CFP, 45-degree field of view, image size 2048x1536.
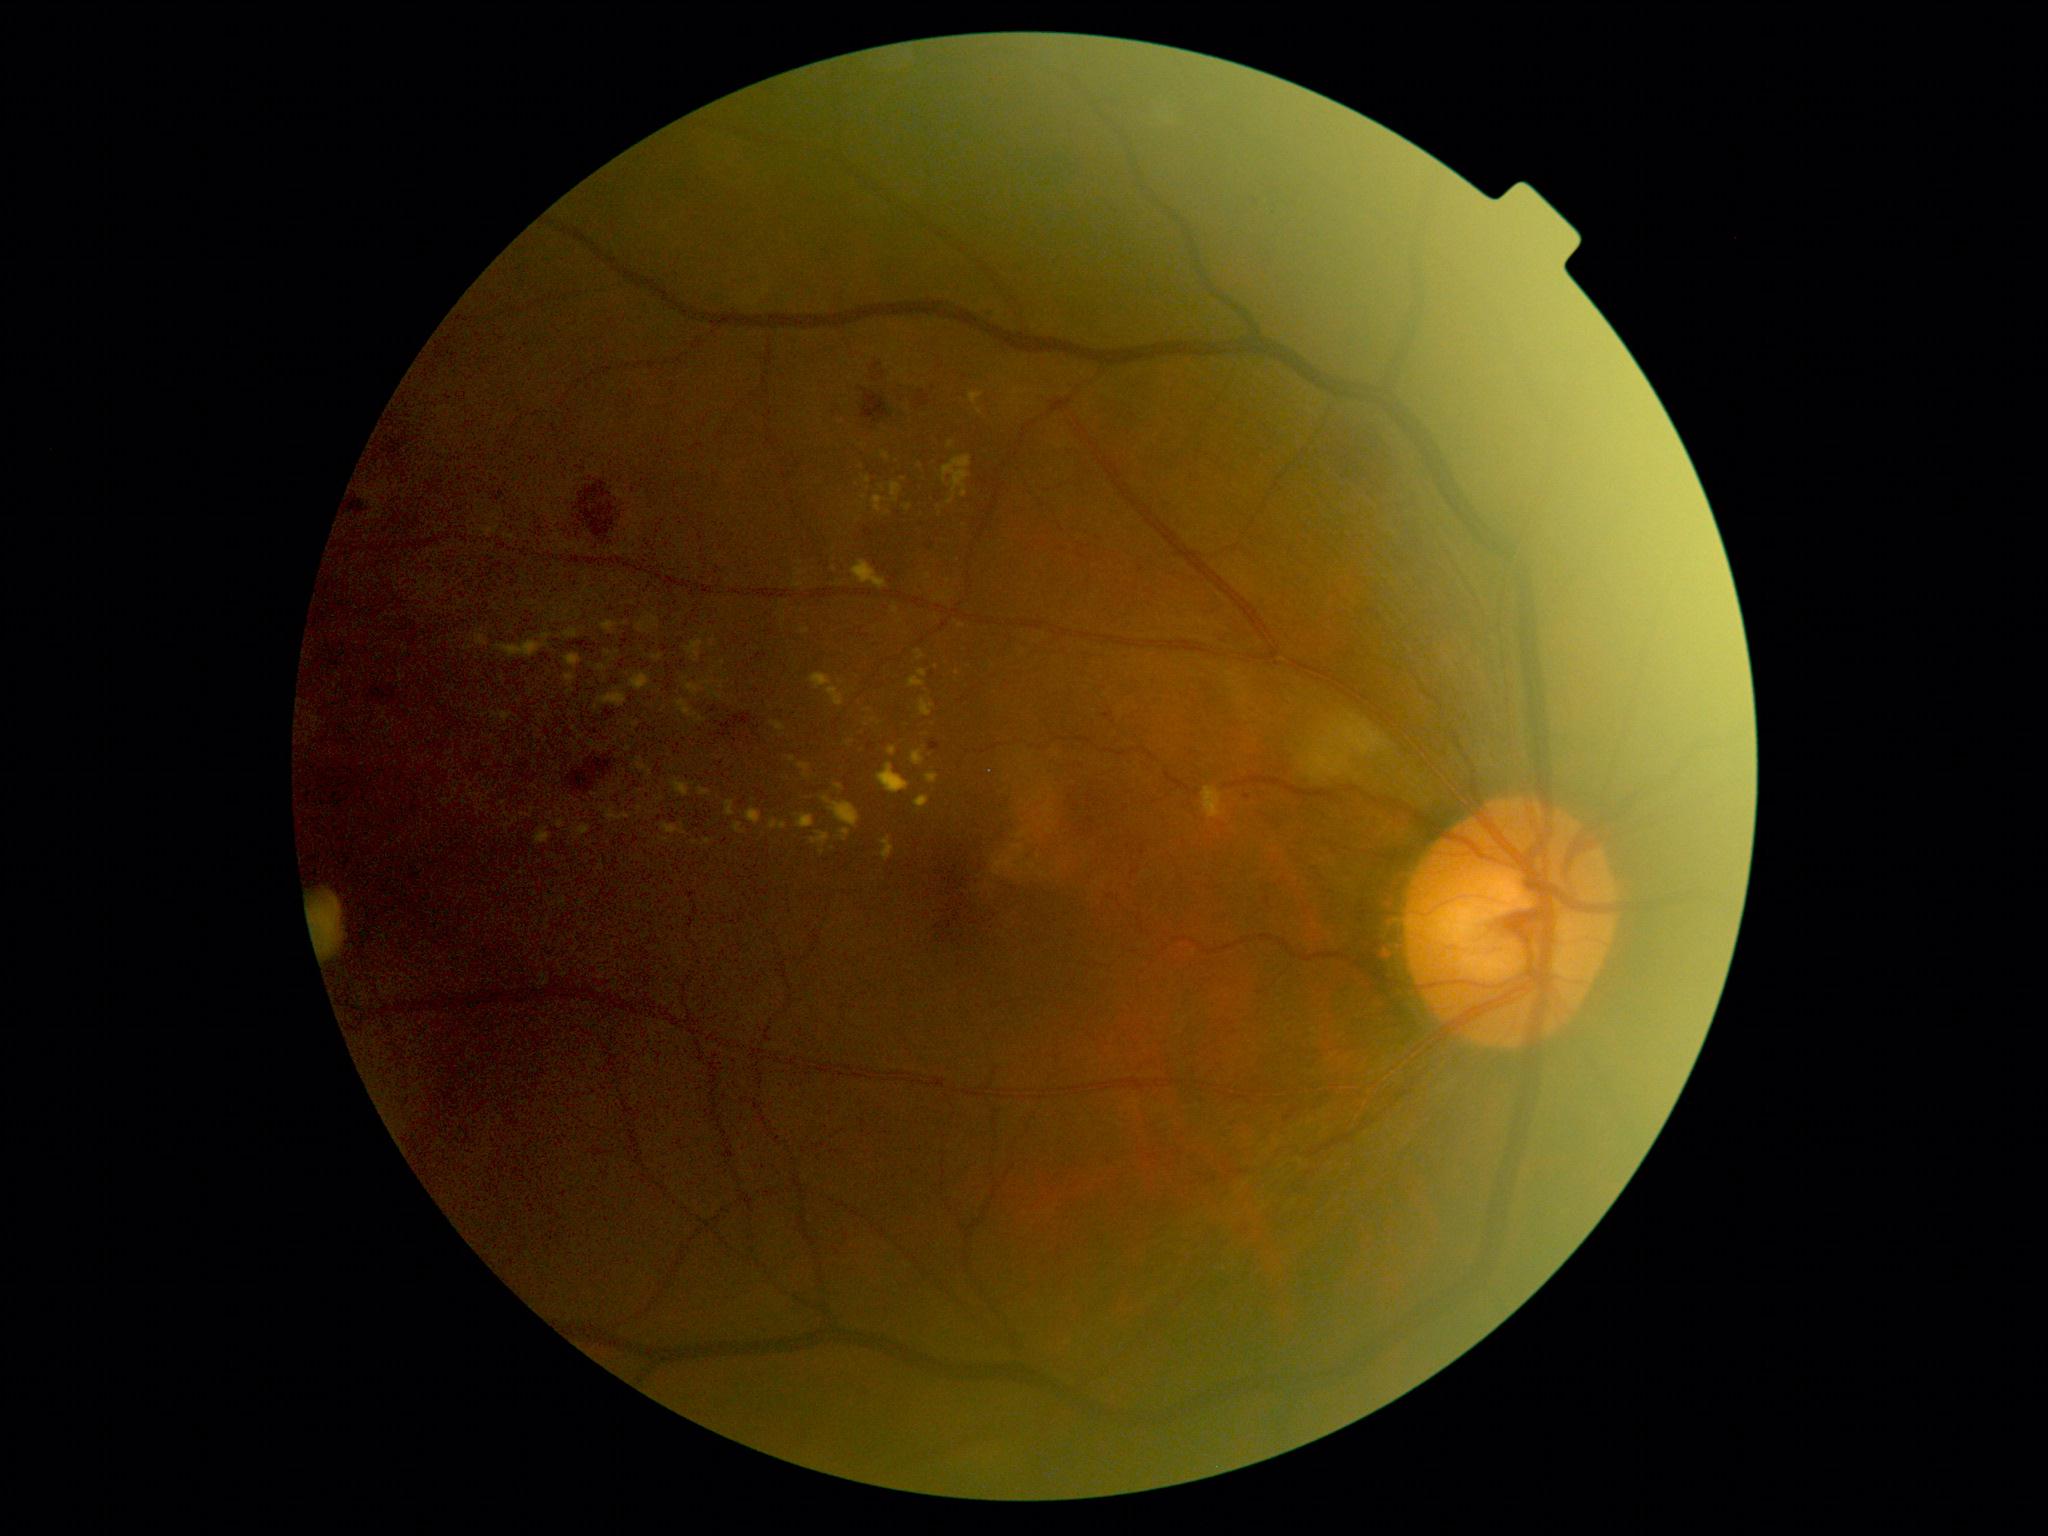 <lesions partial="true">
  <dr_grade>2</dr_grade>
  <ex partial="true">box(831, 803, 860, 828); box(687, 685, 699, 692); box(920, 702, 933, 717); box(883, 839, 895, 859); box(915, 797, 929, 809); box(631, 675, 650, 691); box(812, 835, 830, 843); box(579, 826, 589, 836); box(776, 724, 784, 731); box(926, 774, 938, 784)</ex>
  <ex_small_approx>(574; 729); (697; 654); (921; 657); (546; 637); (774; 825); (784; 826)</ex_small_approx>
</lesions>